Davis DR grading
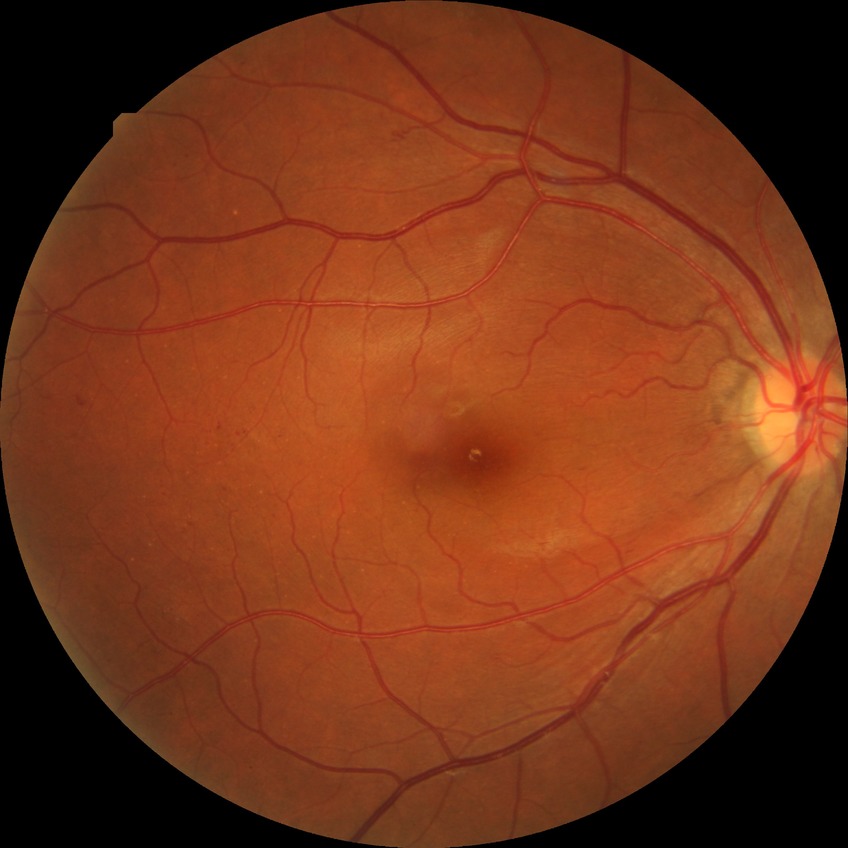
DR grade is SDR.